Infant wide-field retinal image: 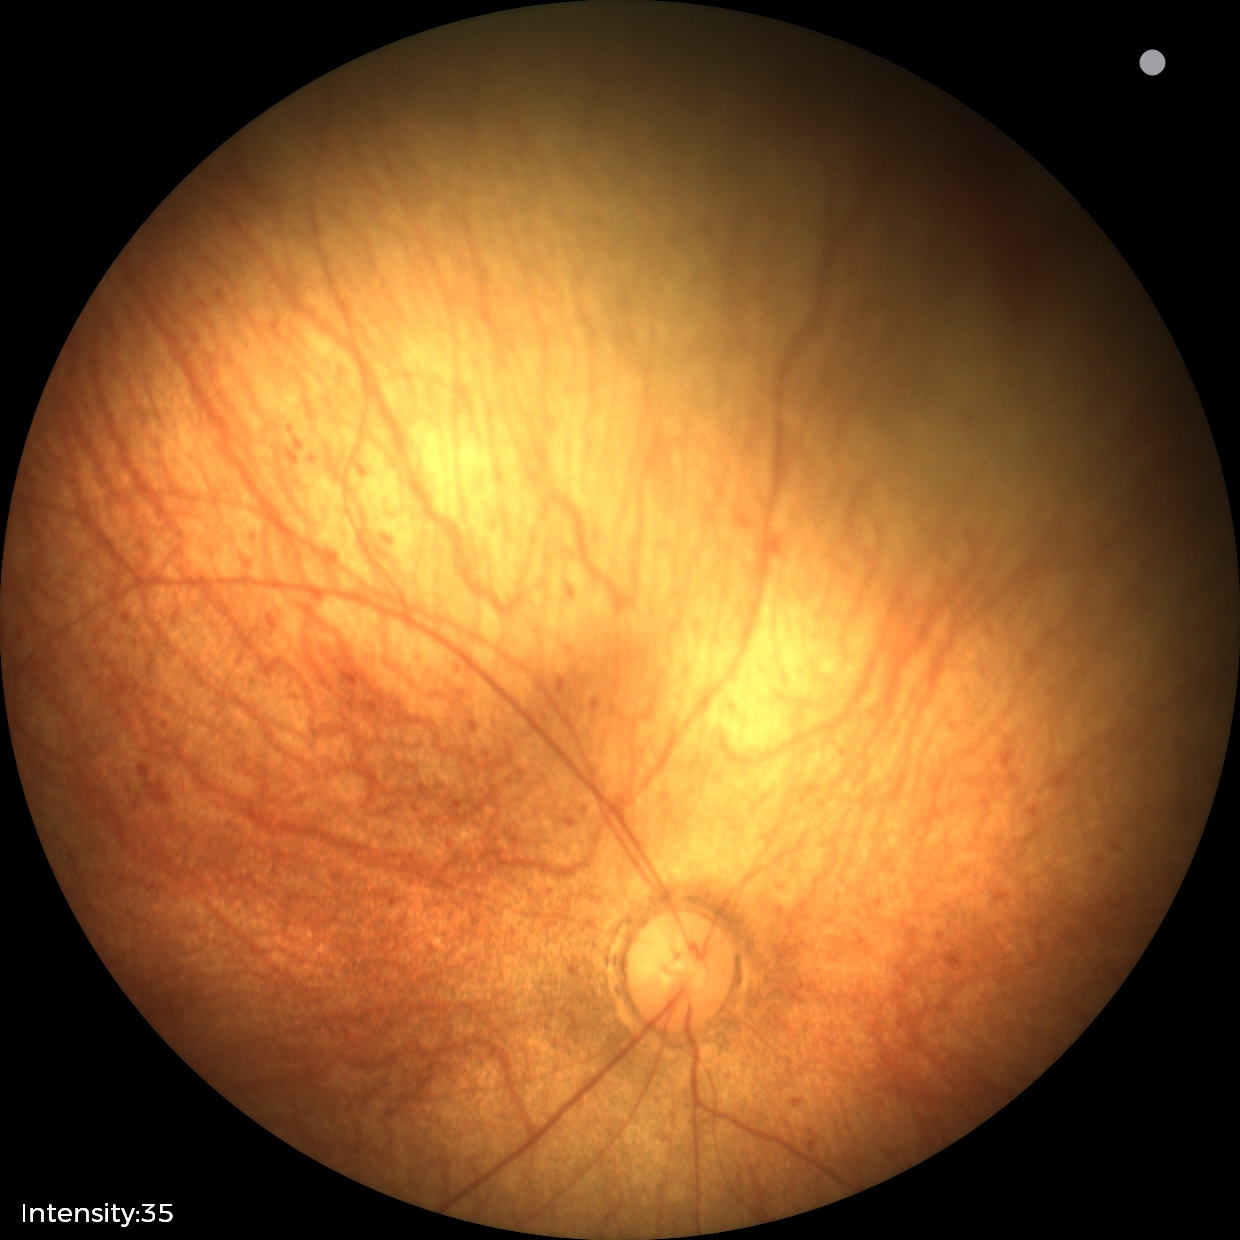

Screening examination diagnosed as physiological.